Nonmydriatic
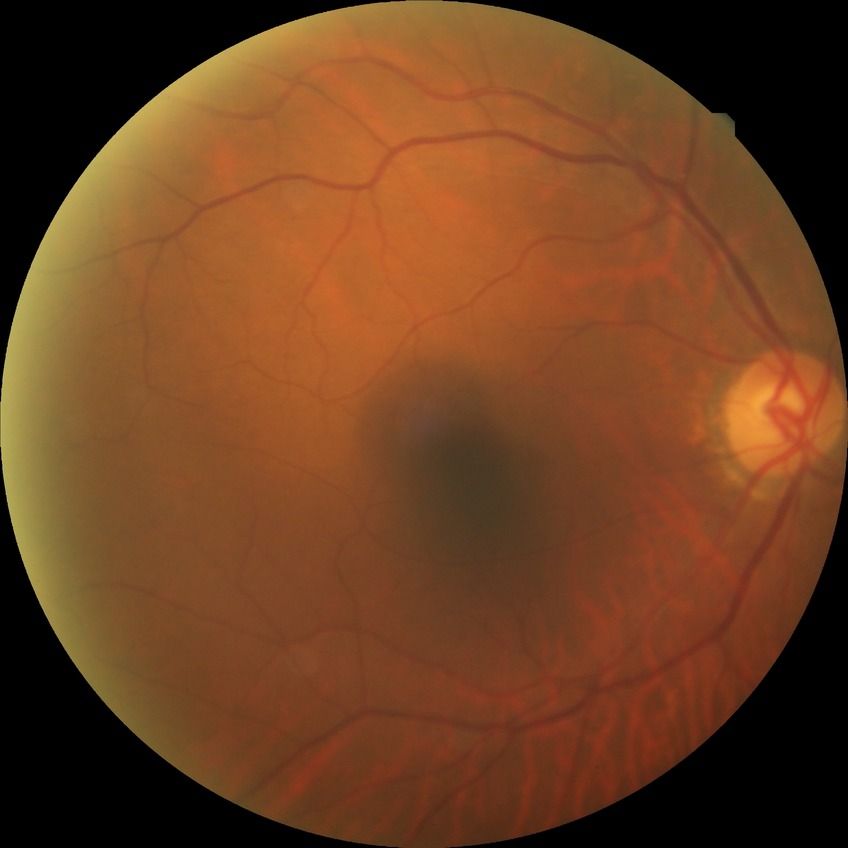
Annotations:
- diabetic retinopathy (DR): NDR (no diabetic retinopathy)